45 degree fundus photograph. Nonmydriatic. 848 by 848 pixels. Posterior pole photograph:
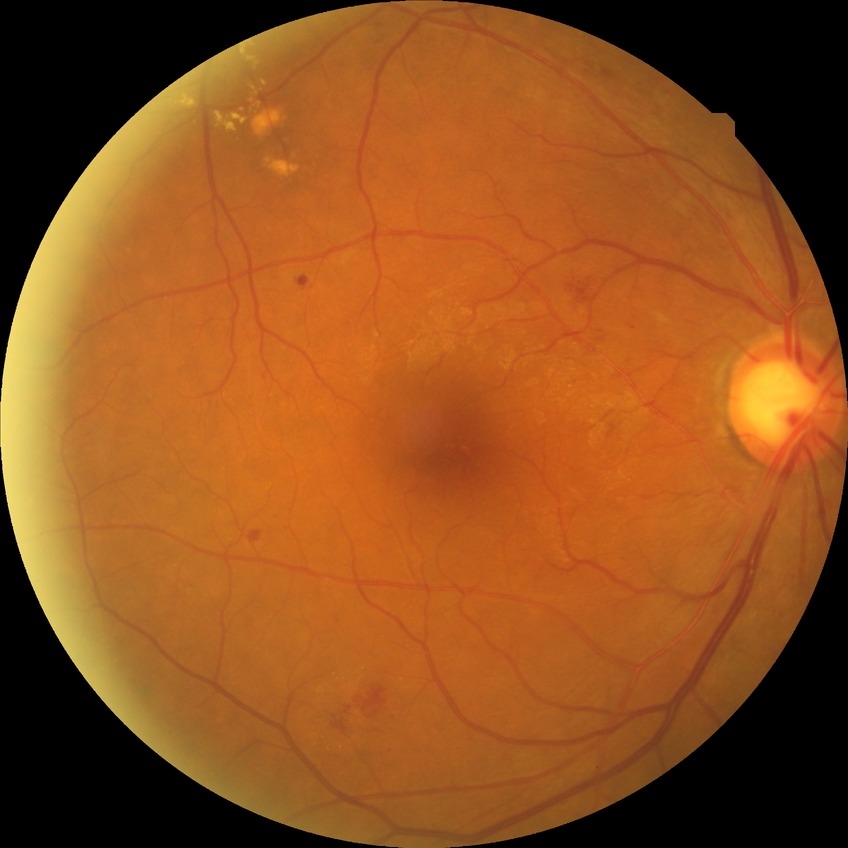 diabetic retinopathy (DR): SDR (simple diabetic retinopathy).